CFP
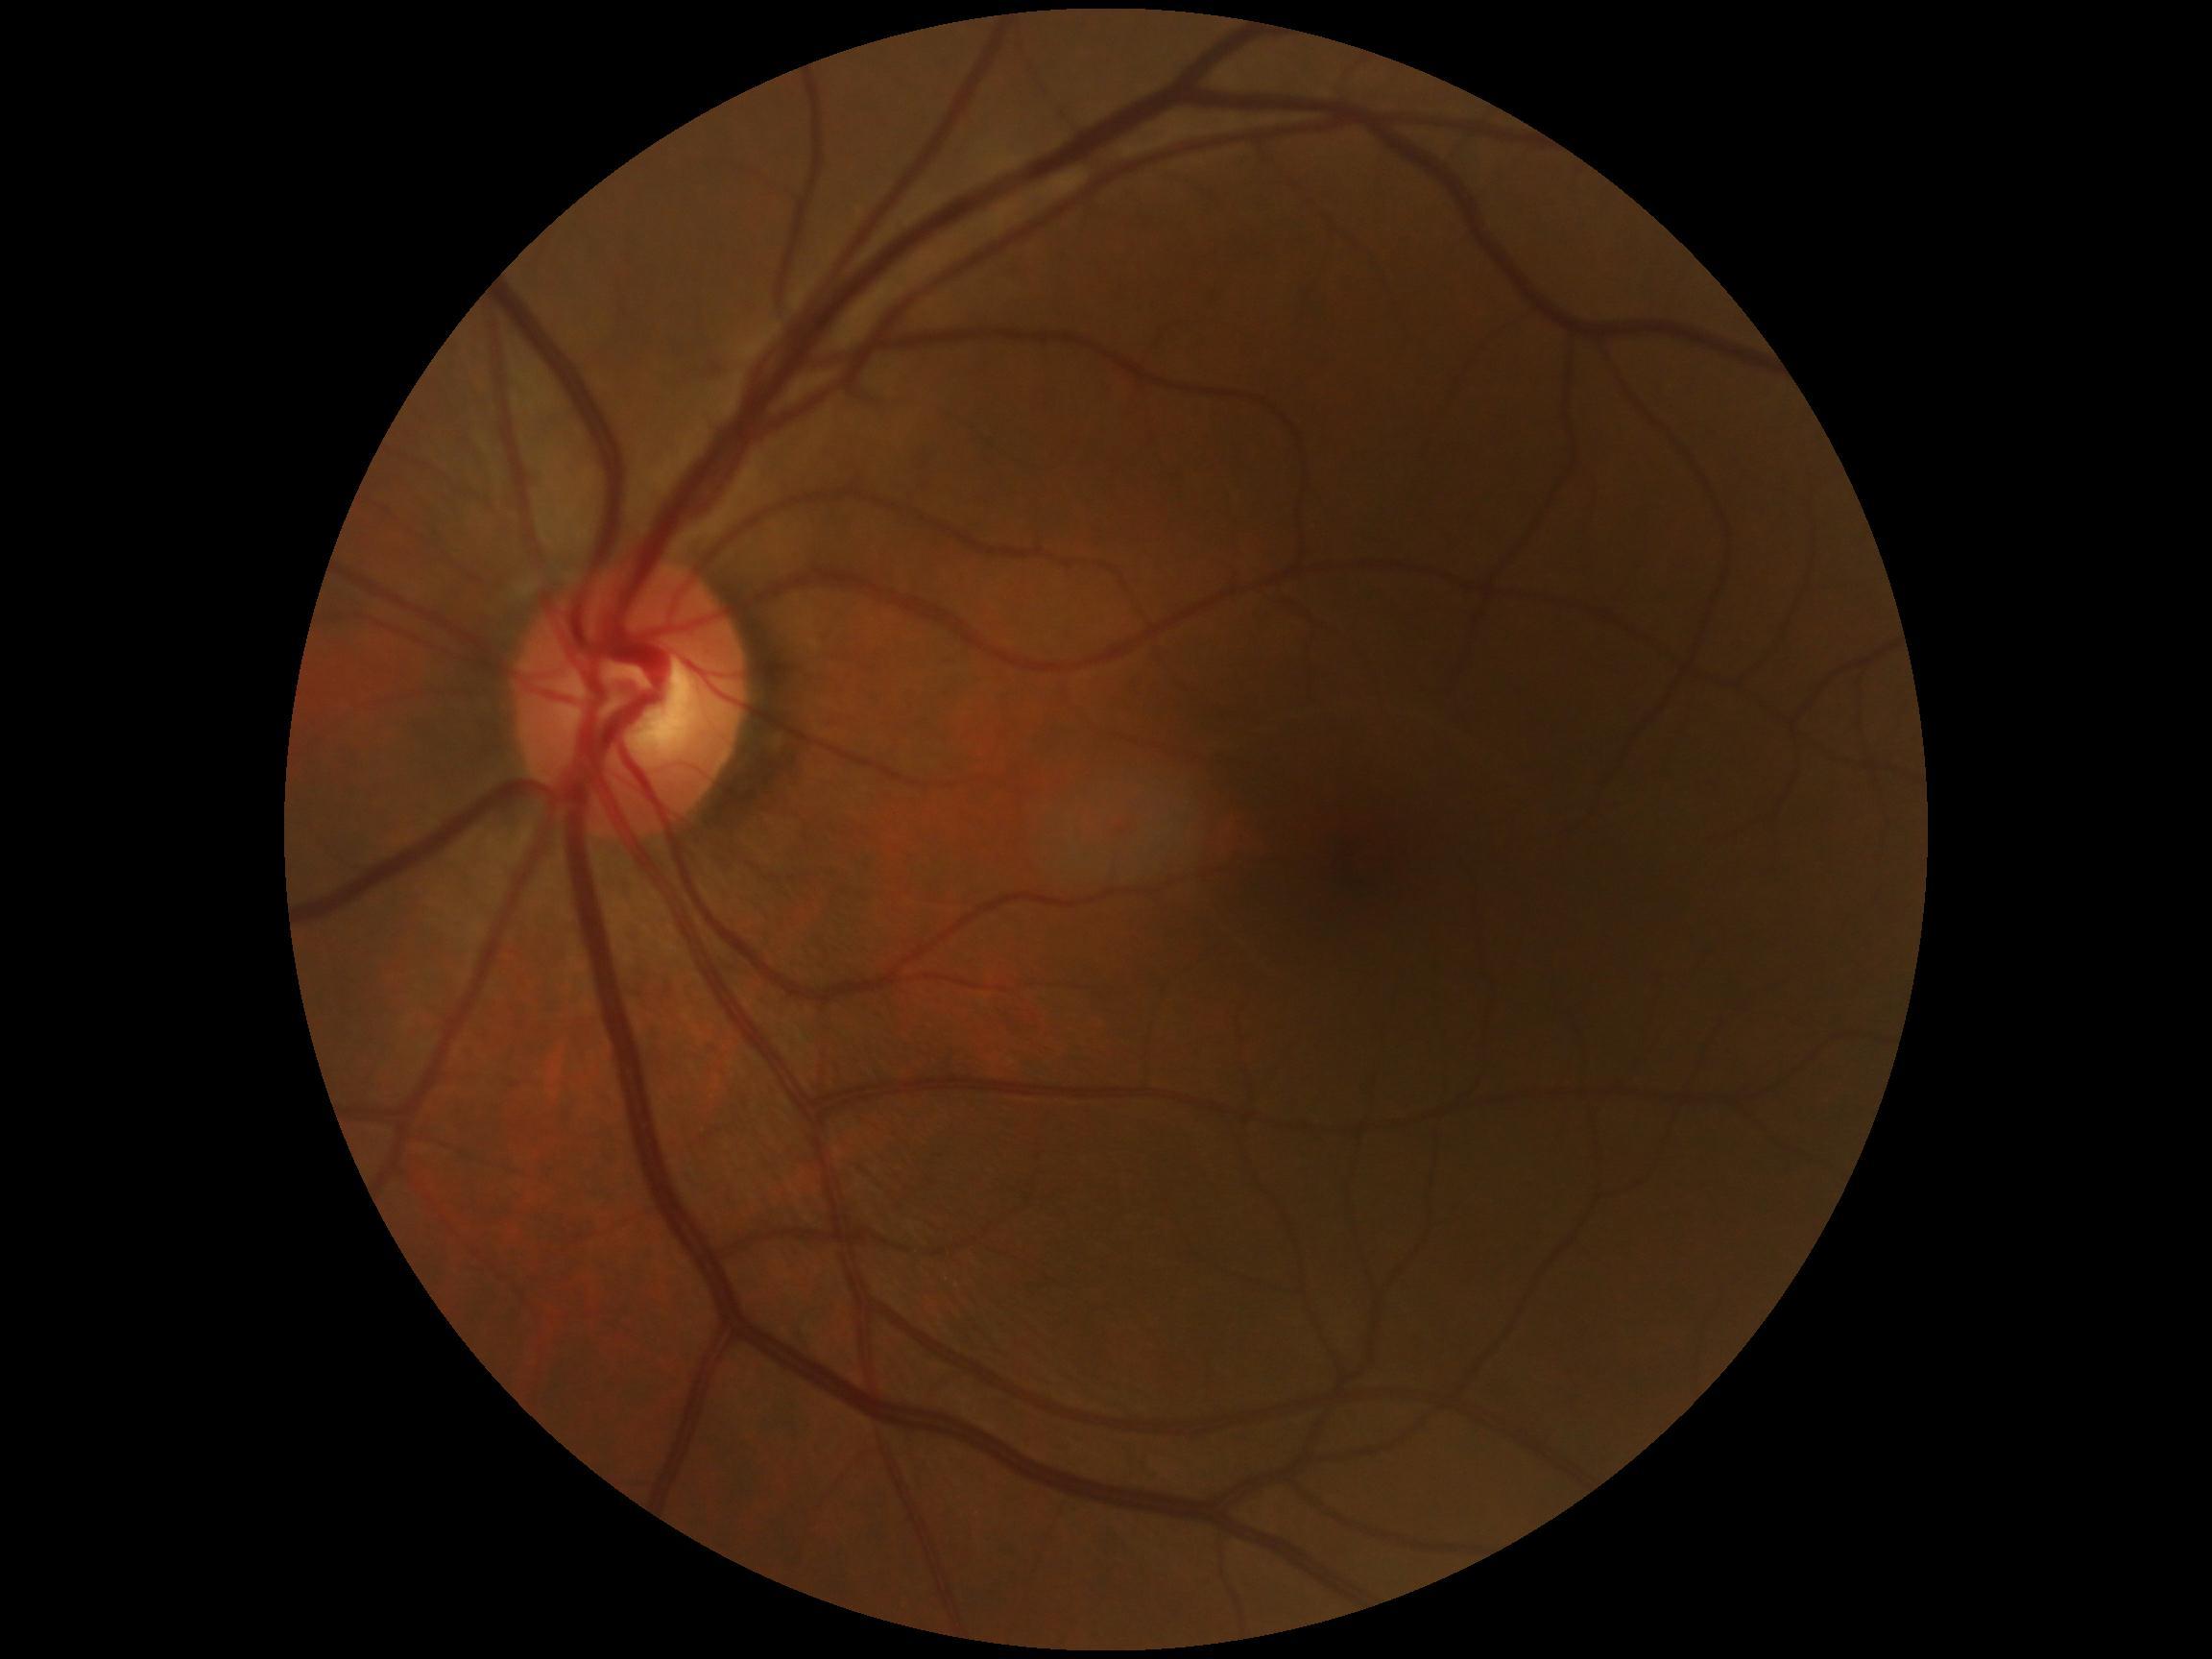 Findings:
- DR impression — no apparent DR
- diabetic retinopathy grade — 0 (no apparent retinopathy) — no visible signs of diabetic retinopathy